Wide-field fundus photograph of an infant. 100° field of view (Phoenix ICON). 1240x1240px.
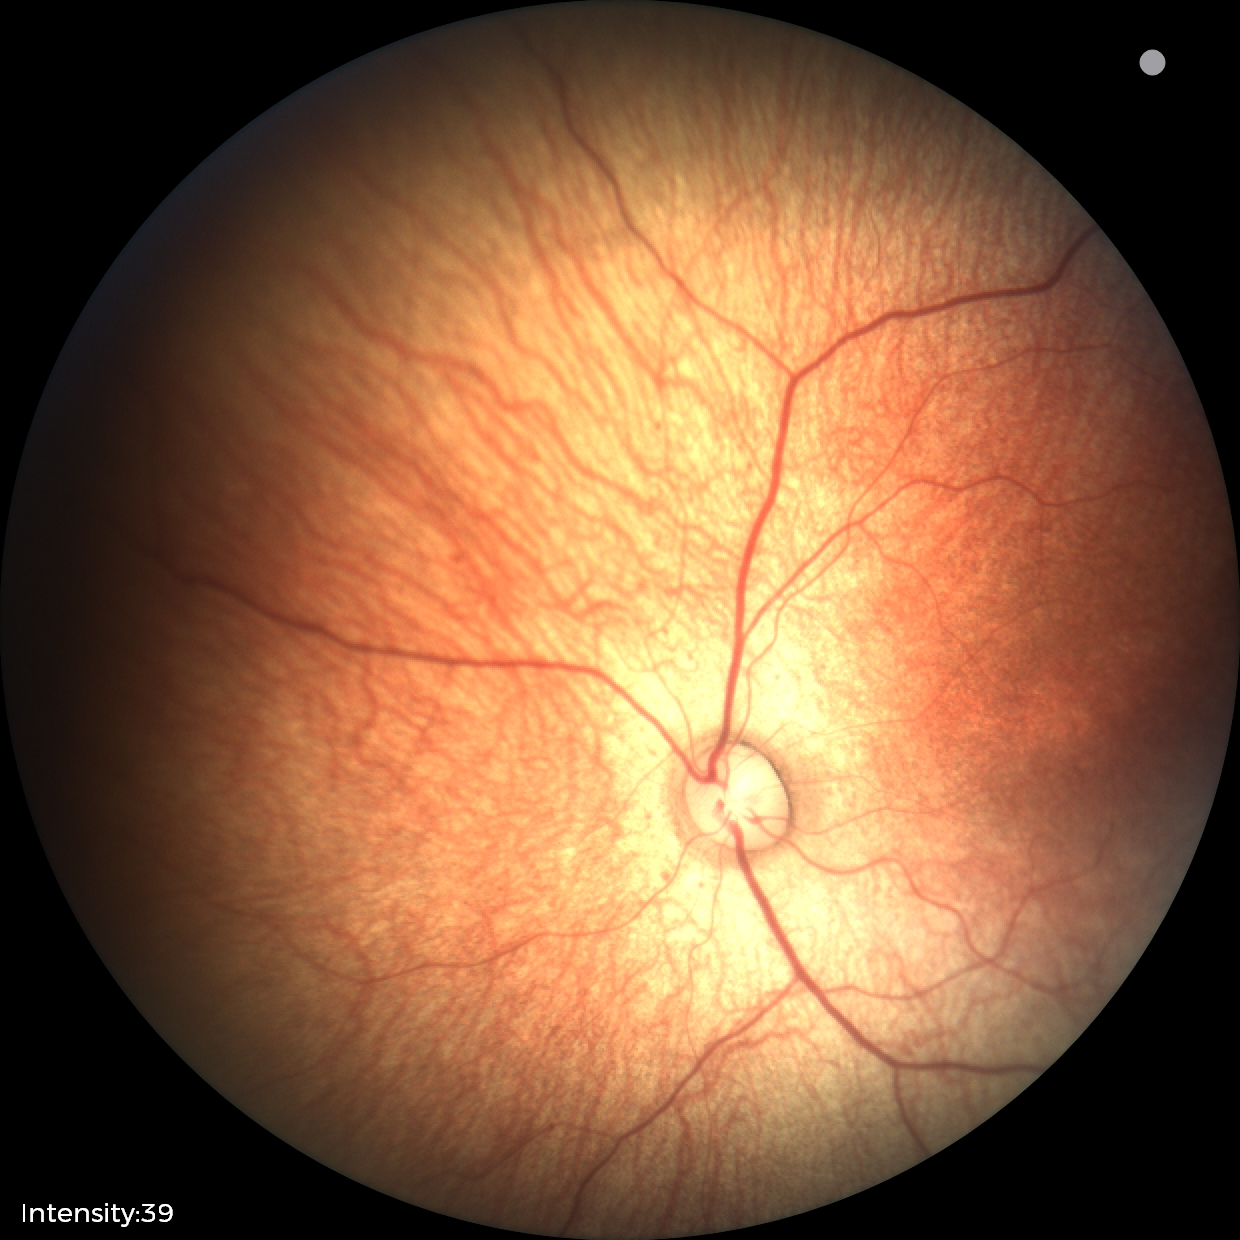 Impression: no abnormalities.